Wide-field fundus photograph of an infant · 1240x1240: 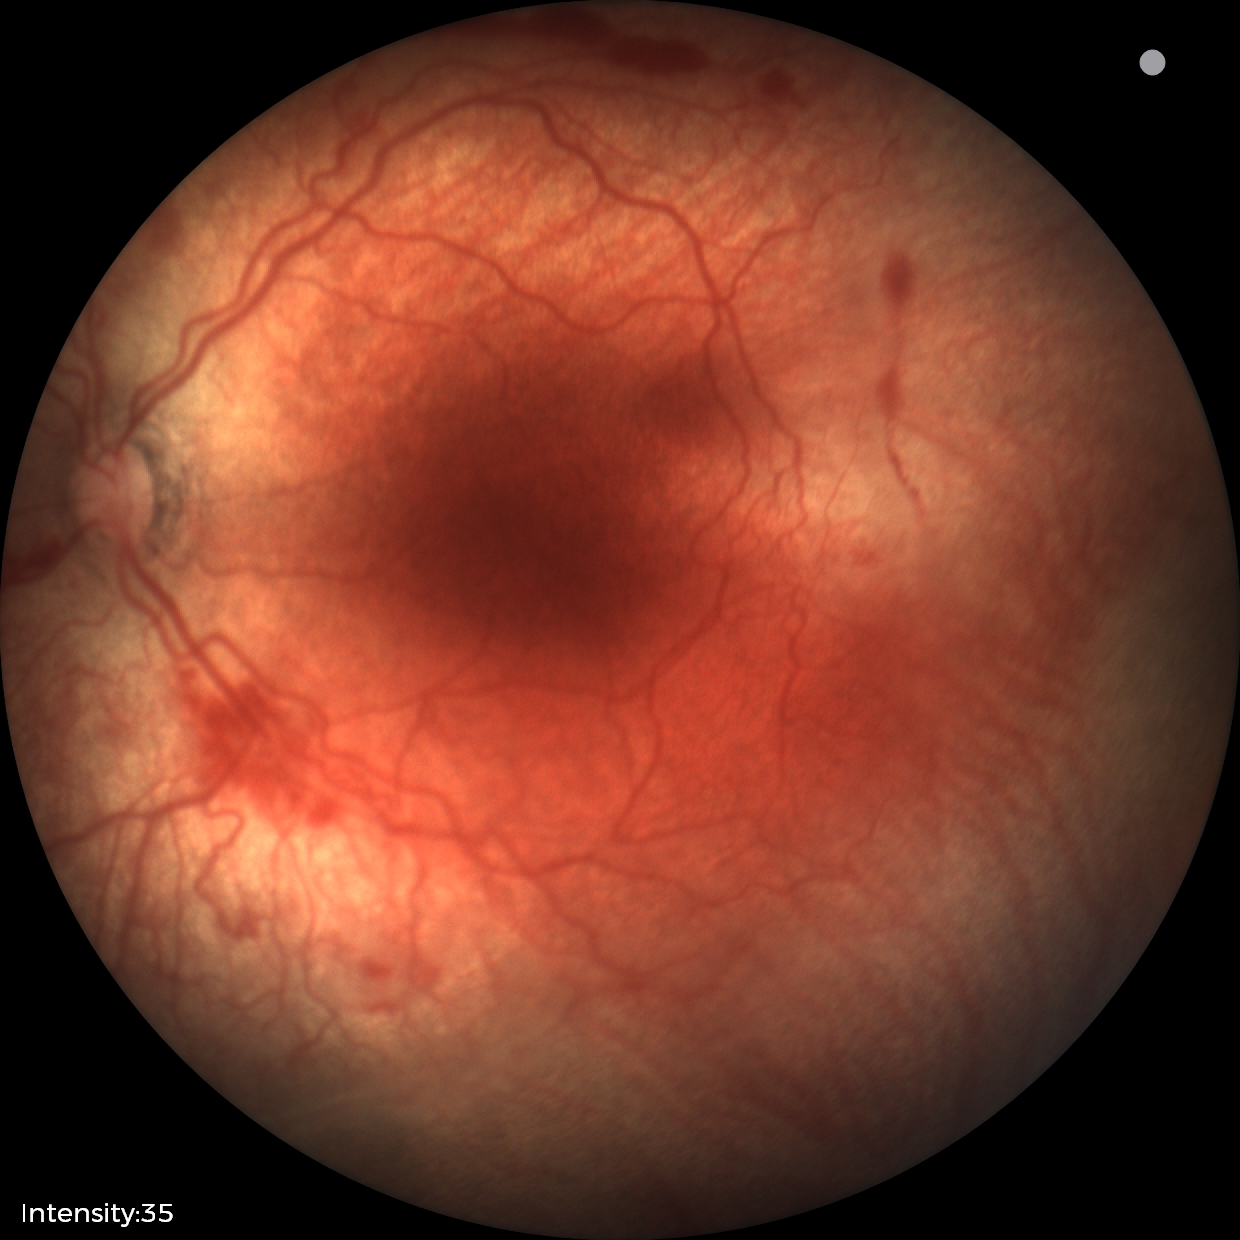 Series diagnosed as ROP stage 2 — ridge with height and width at the demarcation line. Plus disease present.